Pediatric retinal photograph (wide-field); captured with the Phoenix ICON (100° field of view):
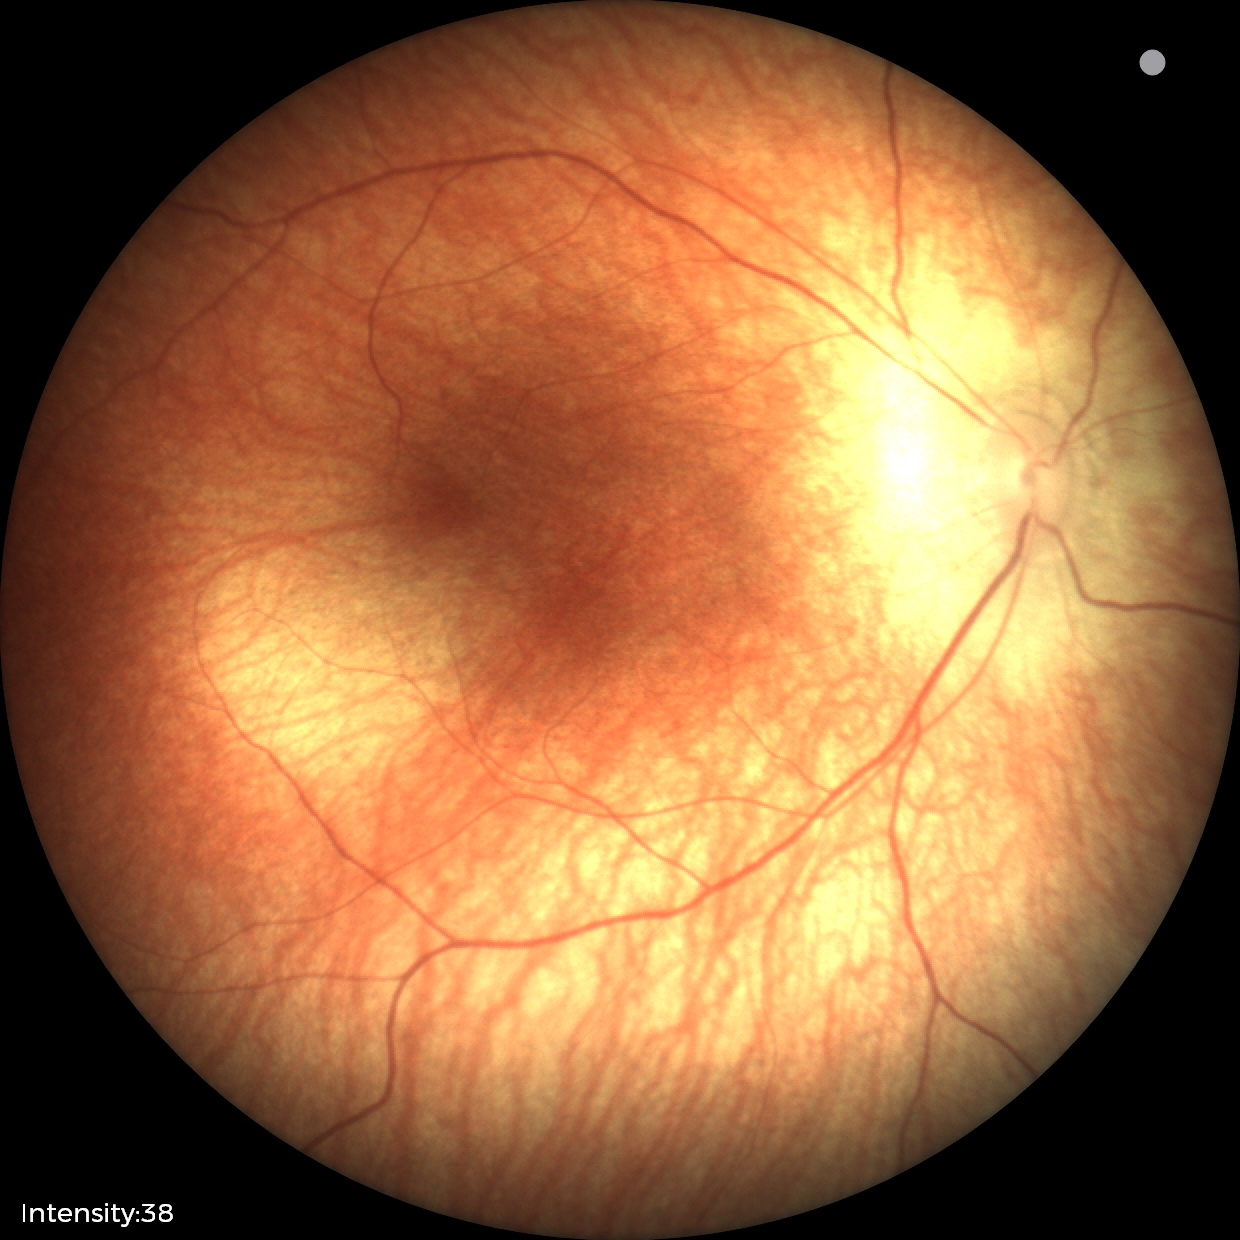
No retinal pathology identified on screening.